CFP. Acquired with a NIDEK AFC-230
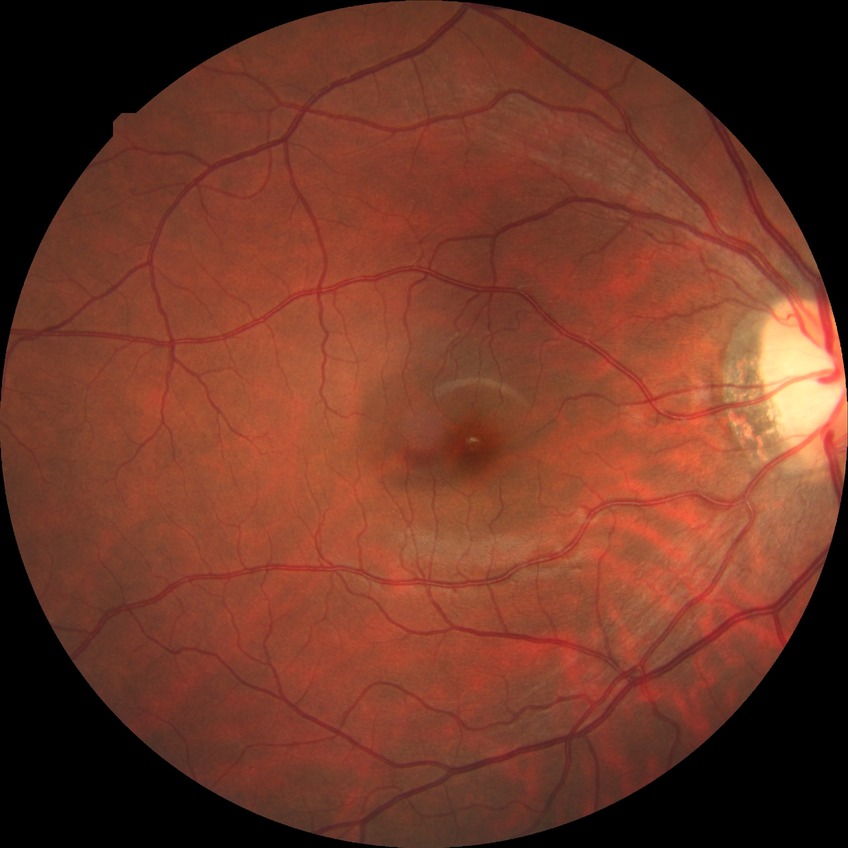
Diabetic retinopathy (DR): no diabetic retinopathy (NDR).